848 x 848 pixels, diabetic retinopathy graded by the modified Davis classification, acquired with a NIDEK AFC-230 — 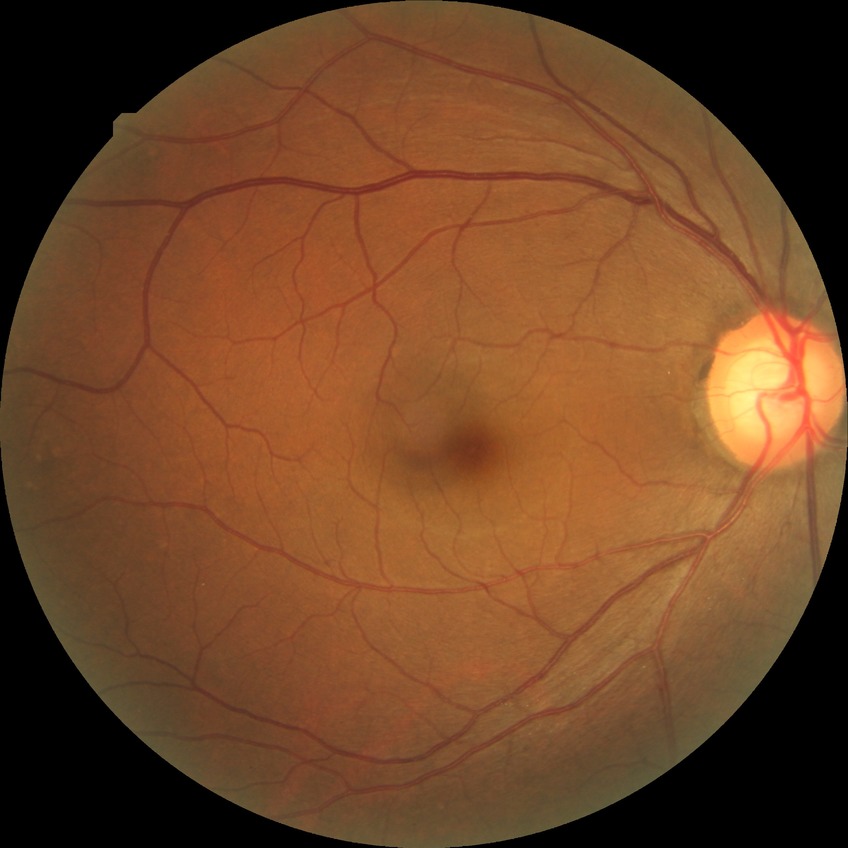

modified Davis grading = no diabetic retinopathy.